Color fundus image, 45-degree field of view — 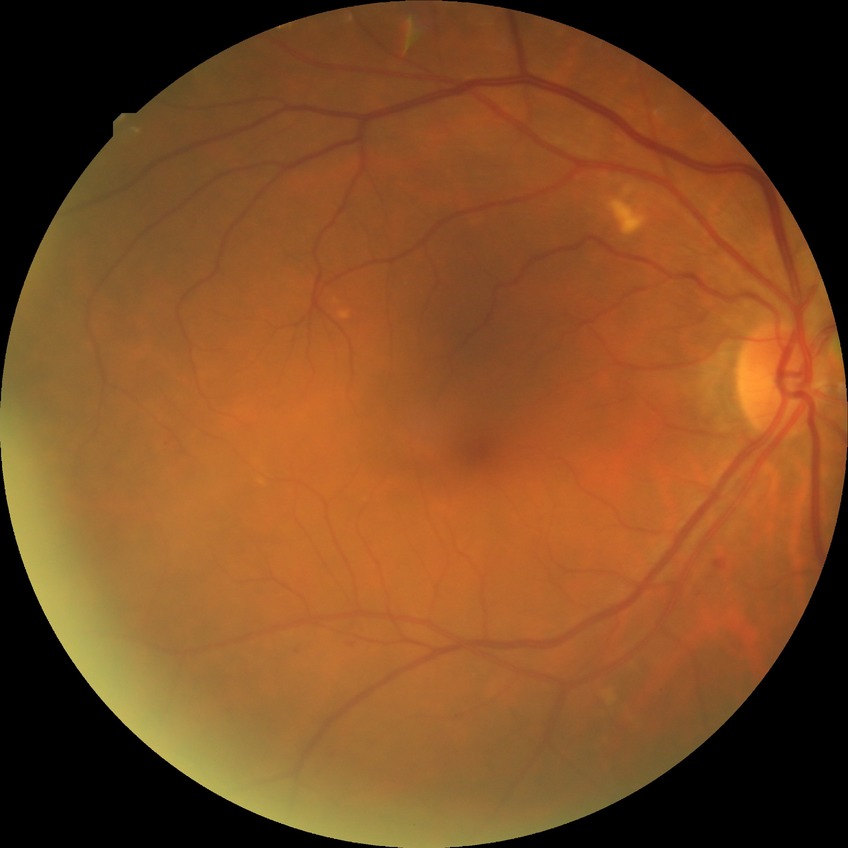
diabetic retinopathy severity: simple diabetic retinopathy.